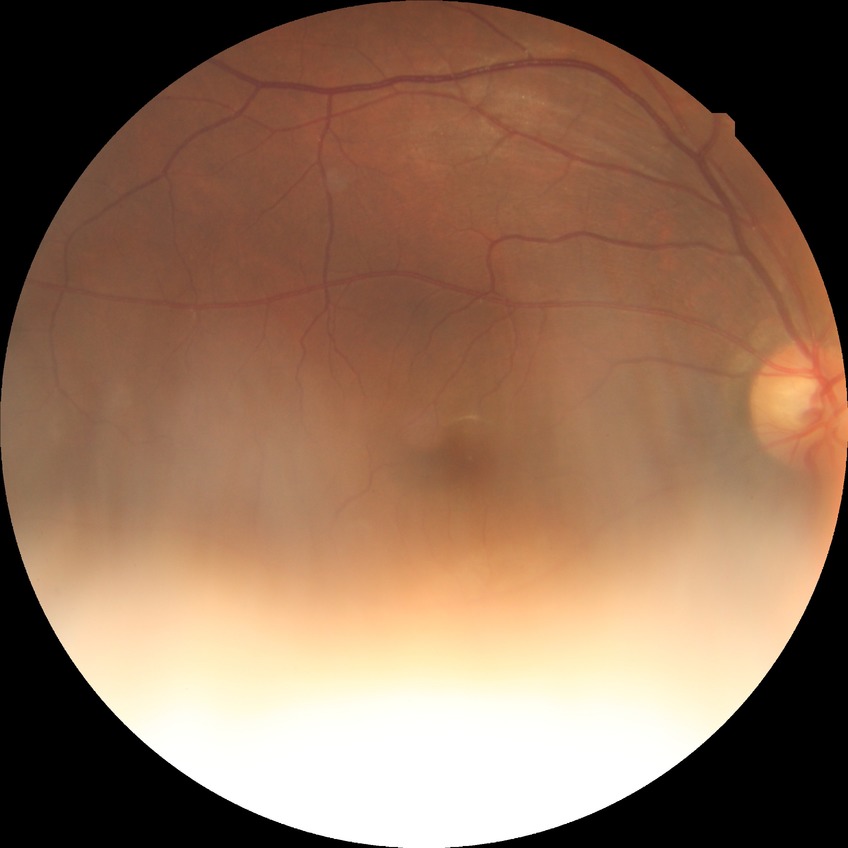 retinopathy grade: no diabetic retinopathy